Retinal fundus photograph: 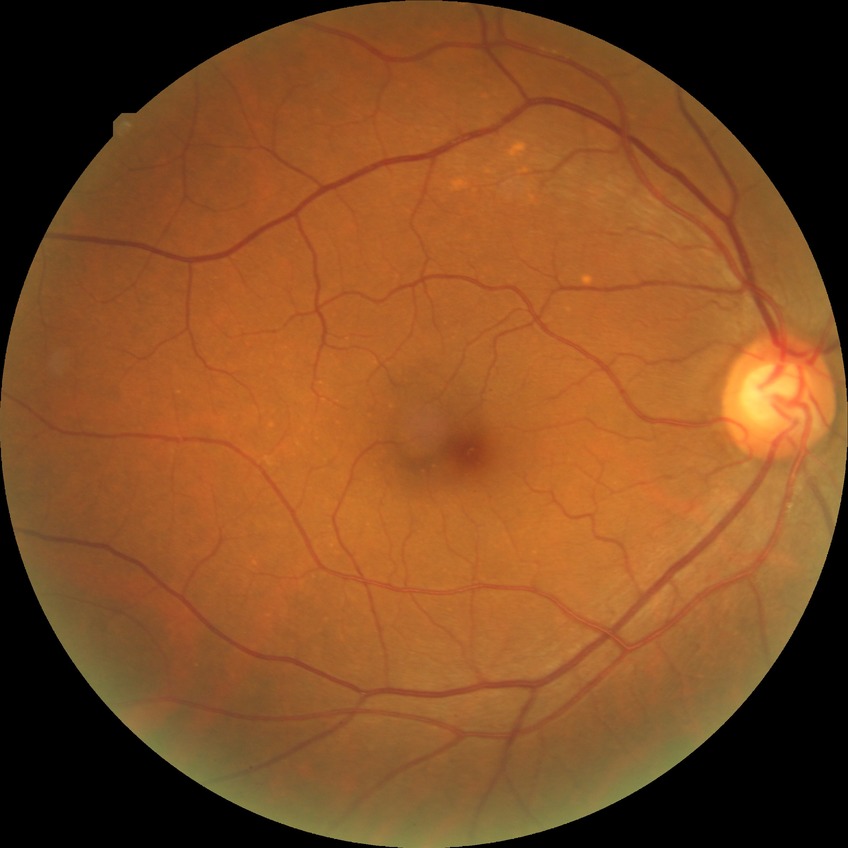
Disease class: non-proliferative diabetic retinopathy.
Diabetic retinopathy (DR): simple diabetic retinopathy (SDR).